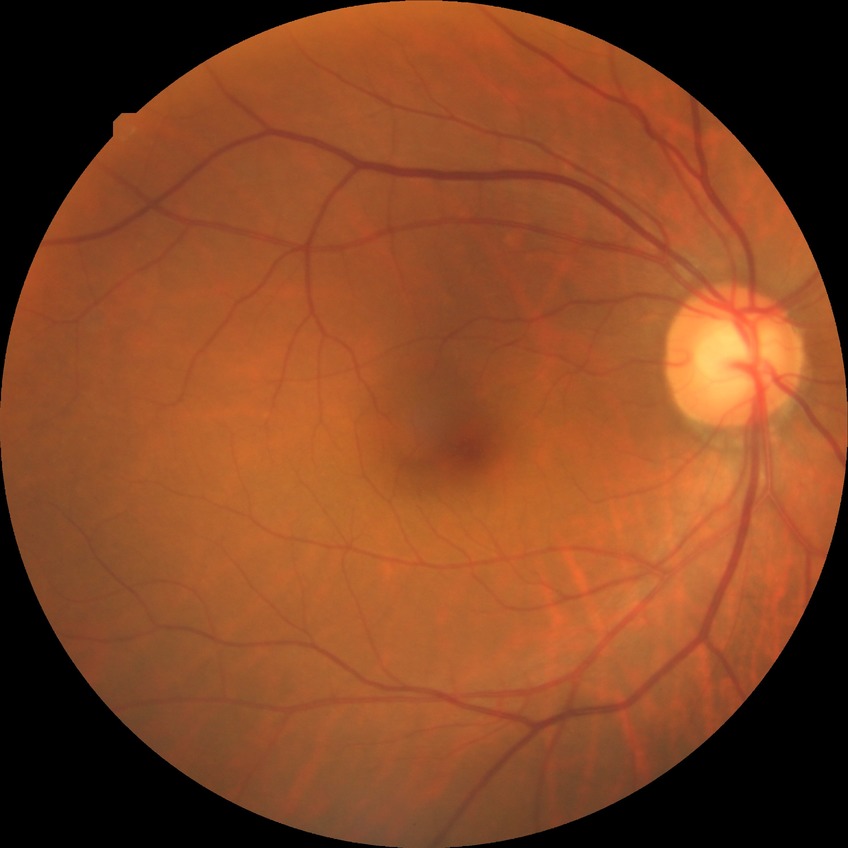 Retinopathy stage is no diabetic retinopathy.